Retinal fundus photograph. 45-degree field of view. 2048 by 1536 pixels — 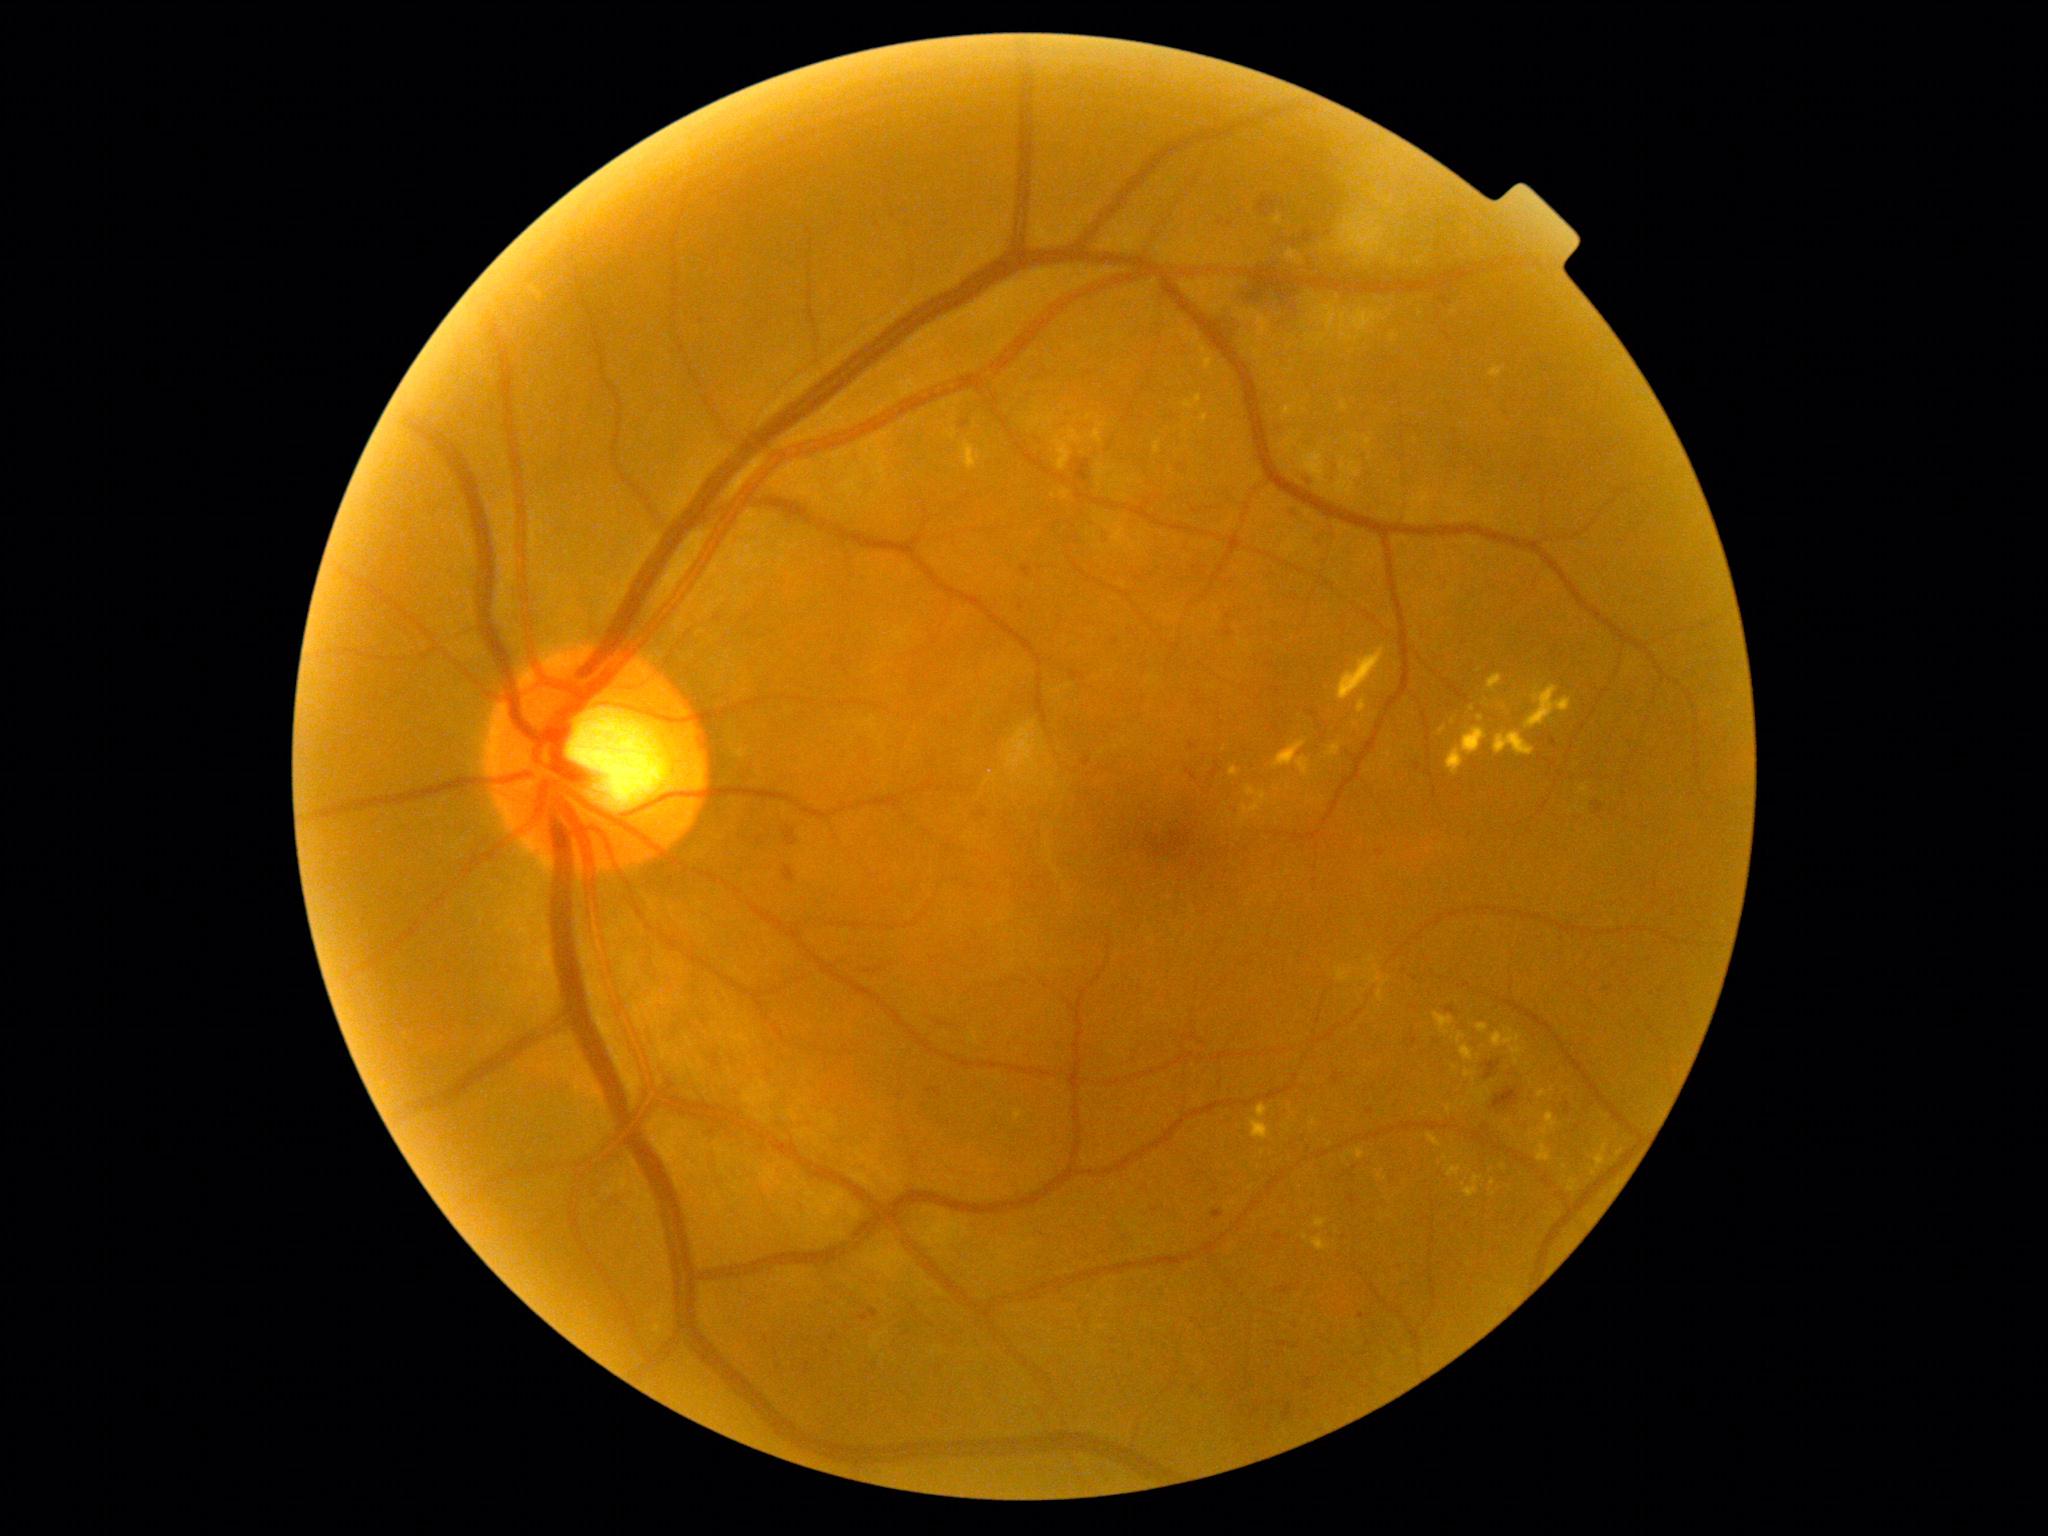 partial: true
dr_grade: 2
dr_grade_name: moderate NPDR
lesions:
  ex:
    - region(1092, 428, 1104, 444)
    - region(1494, 732, 1535, 756)
    - region(1463, 1070, 1476, 1078)
    - region(1489, 367, 1504, 378)
    - region(1230, 766, 1240, 778)
    - region(1488, 674, 1502, 692)
    - region(1183, 394, 1203, 410)
    - region(1525, 686, 1572, 729)
    - region(1055, 441, 1072, 471)
    - region(1356, 1147, 1366, 1160)
    - region(1439, 727, 1446, 735)
    - region(1538, 1090, 1548, 1098)
  ex_small_centers:
    - 1504:1167
    - 1481:719
    - 1493:1183
    - 1453:722